2352x1568px · retinal fundus photograph
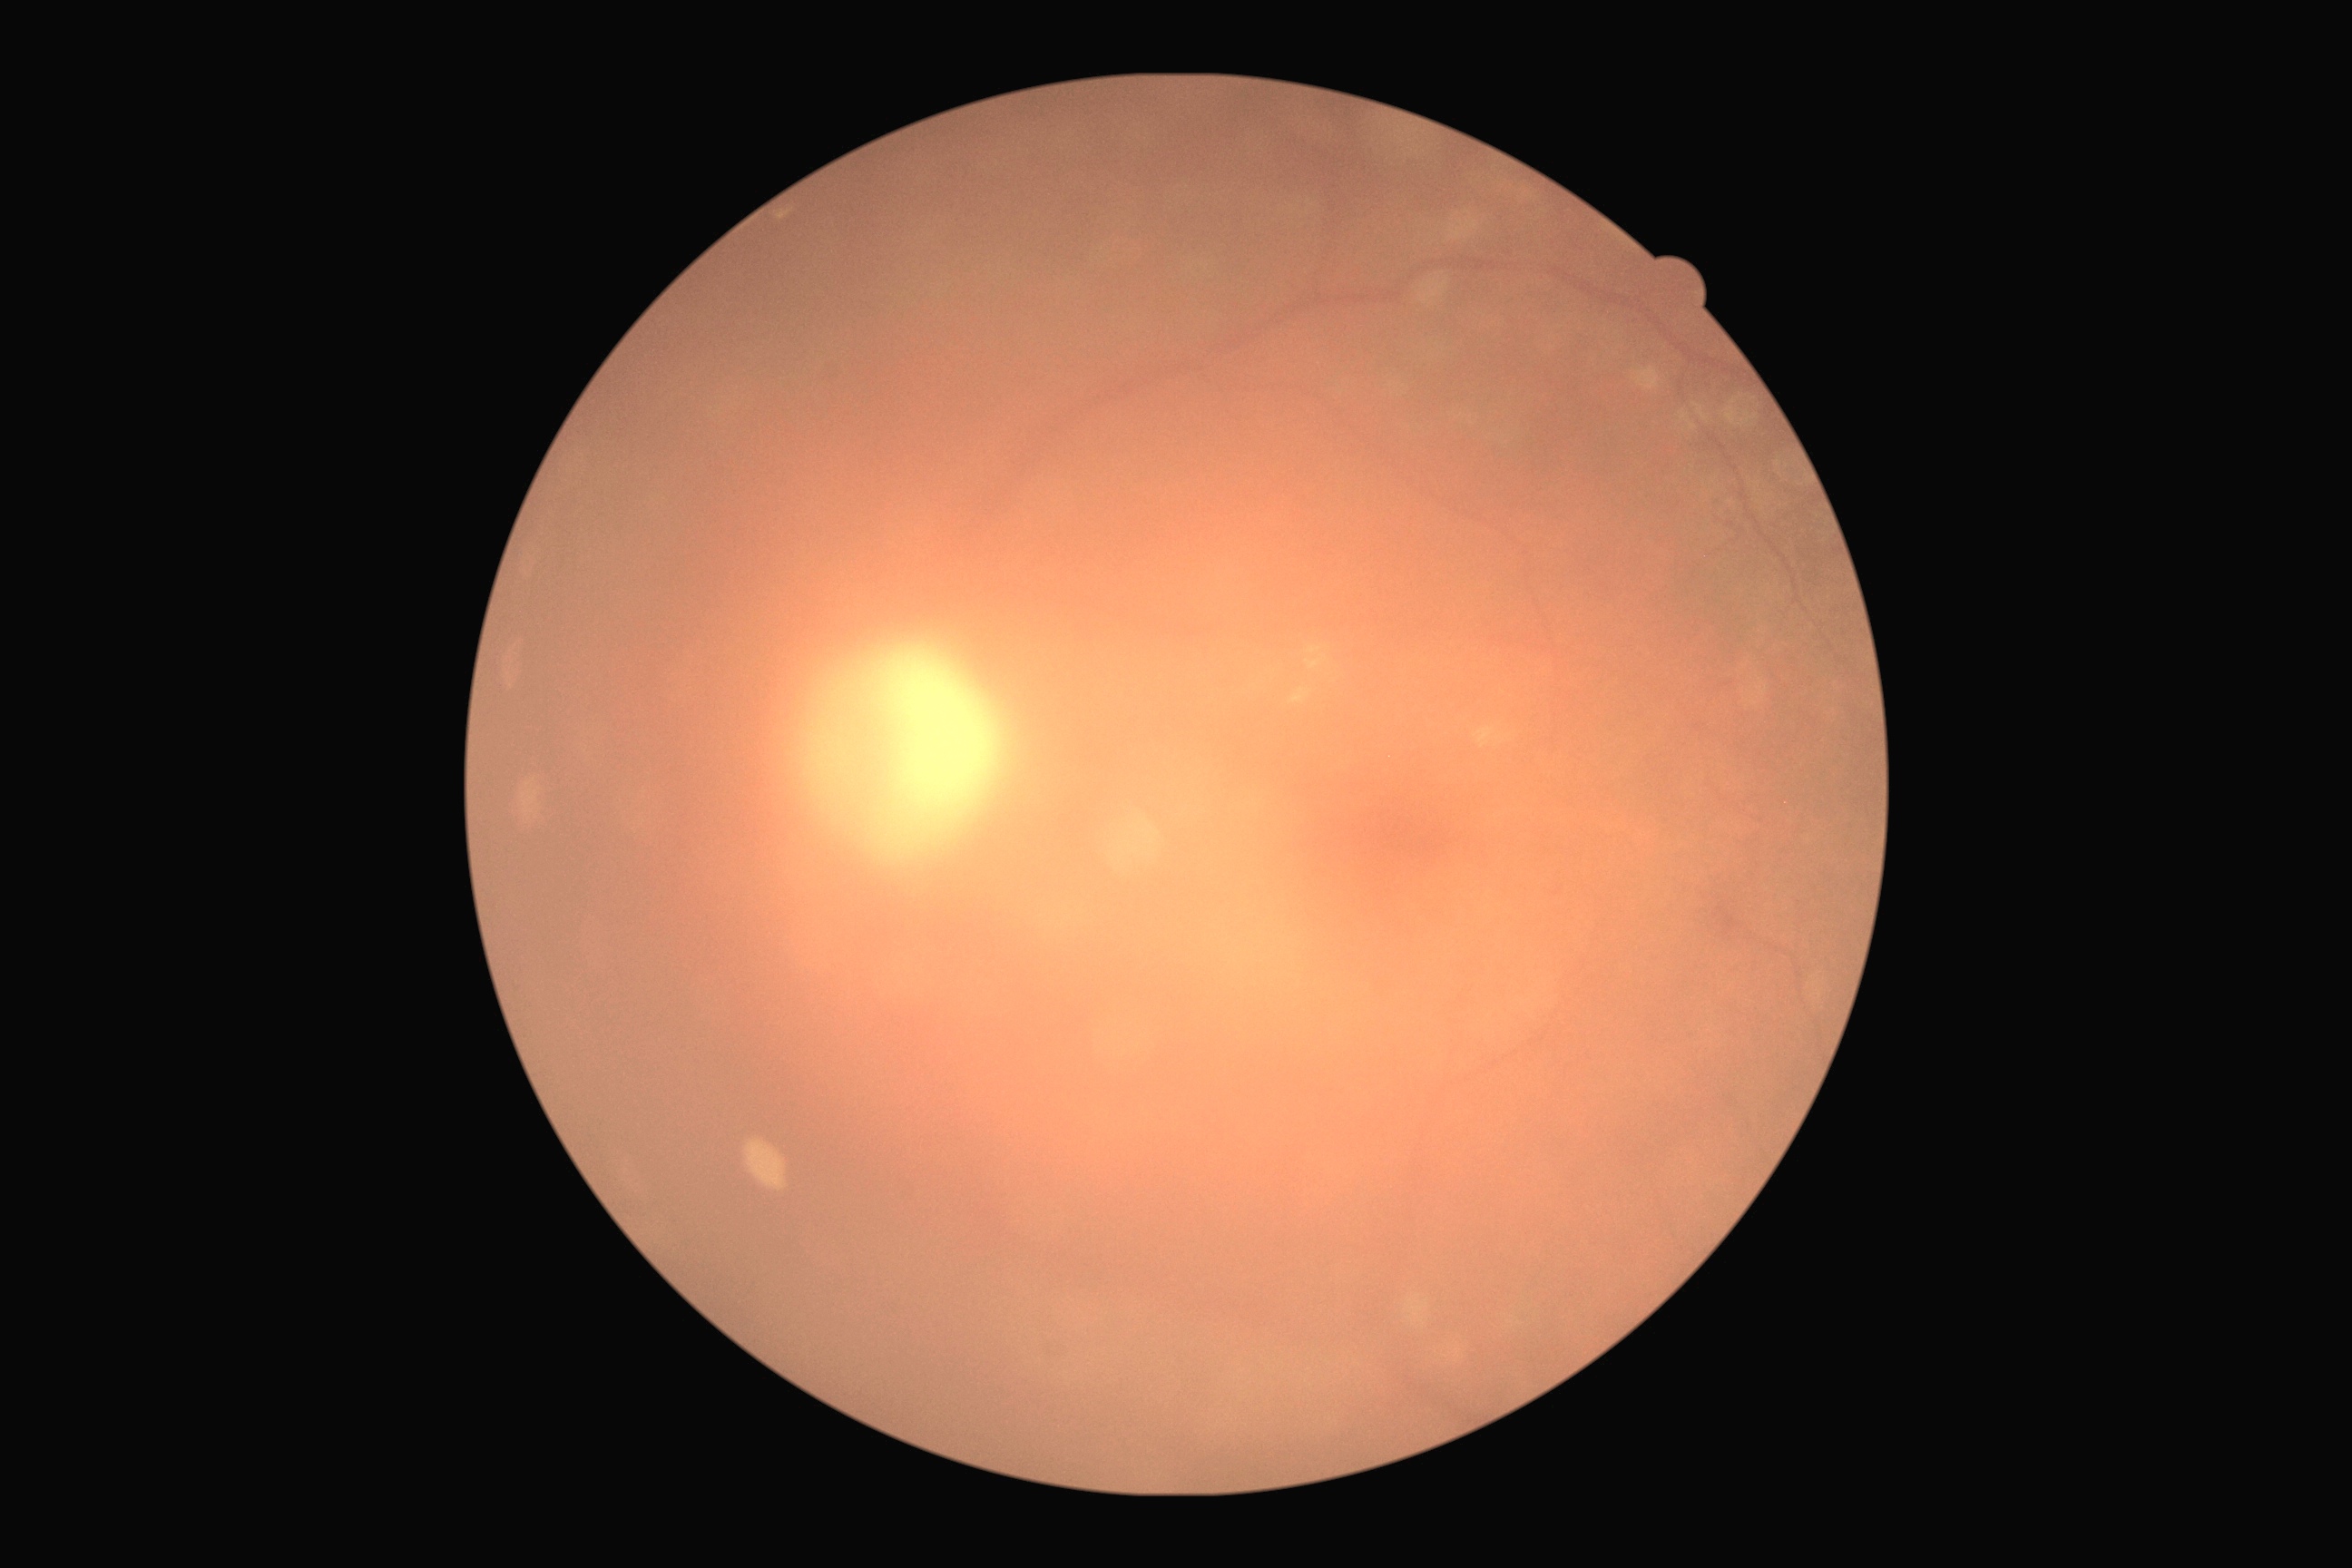 DR stage: ungradable; image quality: insufficient for DR assessment.